45° field of view:
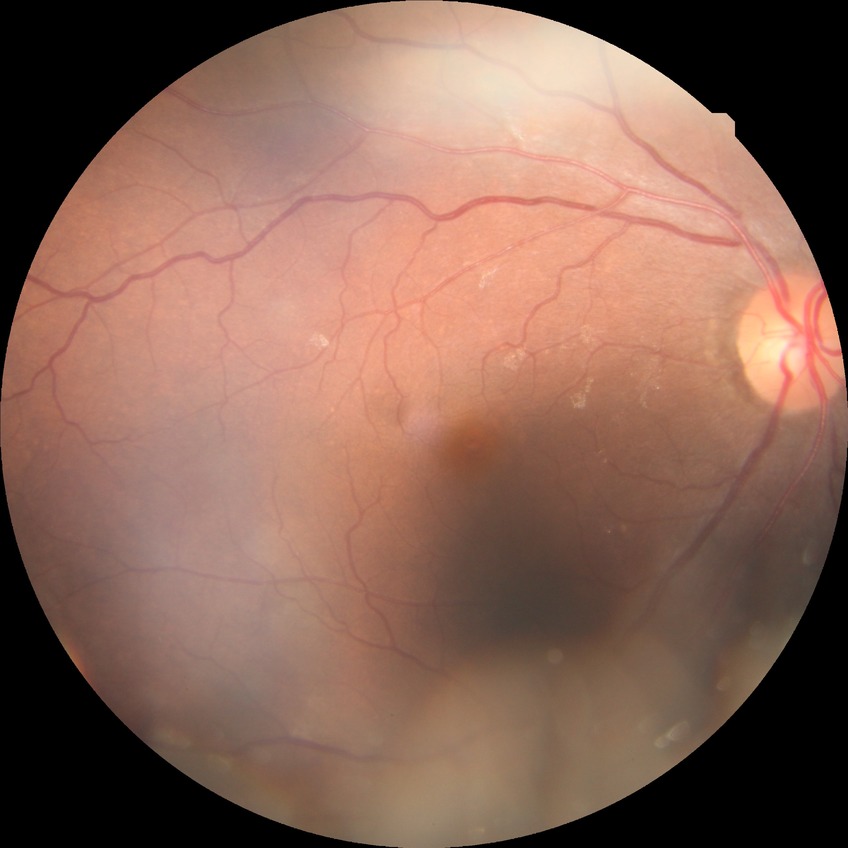 DR impression=no signs of DR, modified Davis grade=NDR.